1659 by 2212 pixels; retinal fundus photograph; Remidio FOP fundus camera — 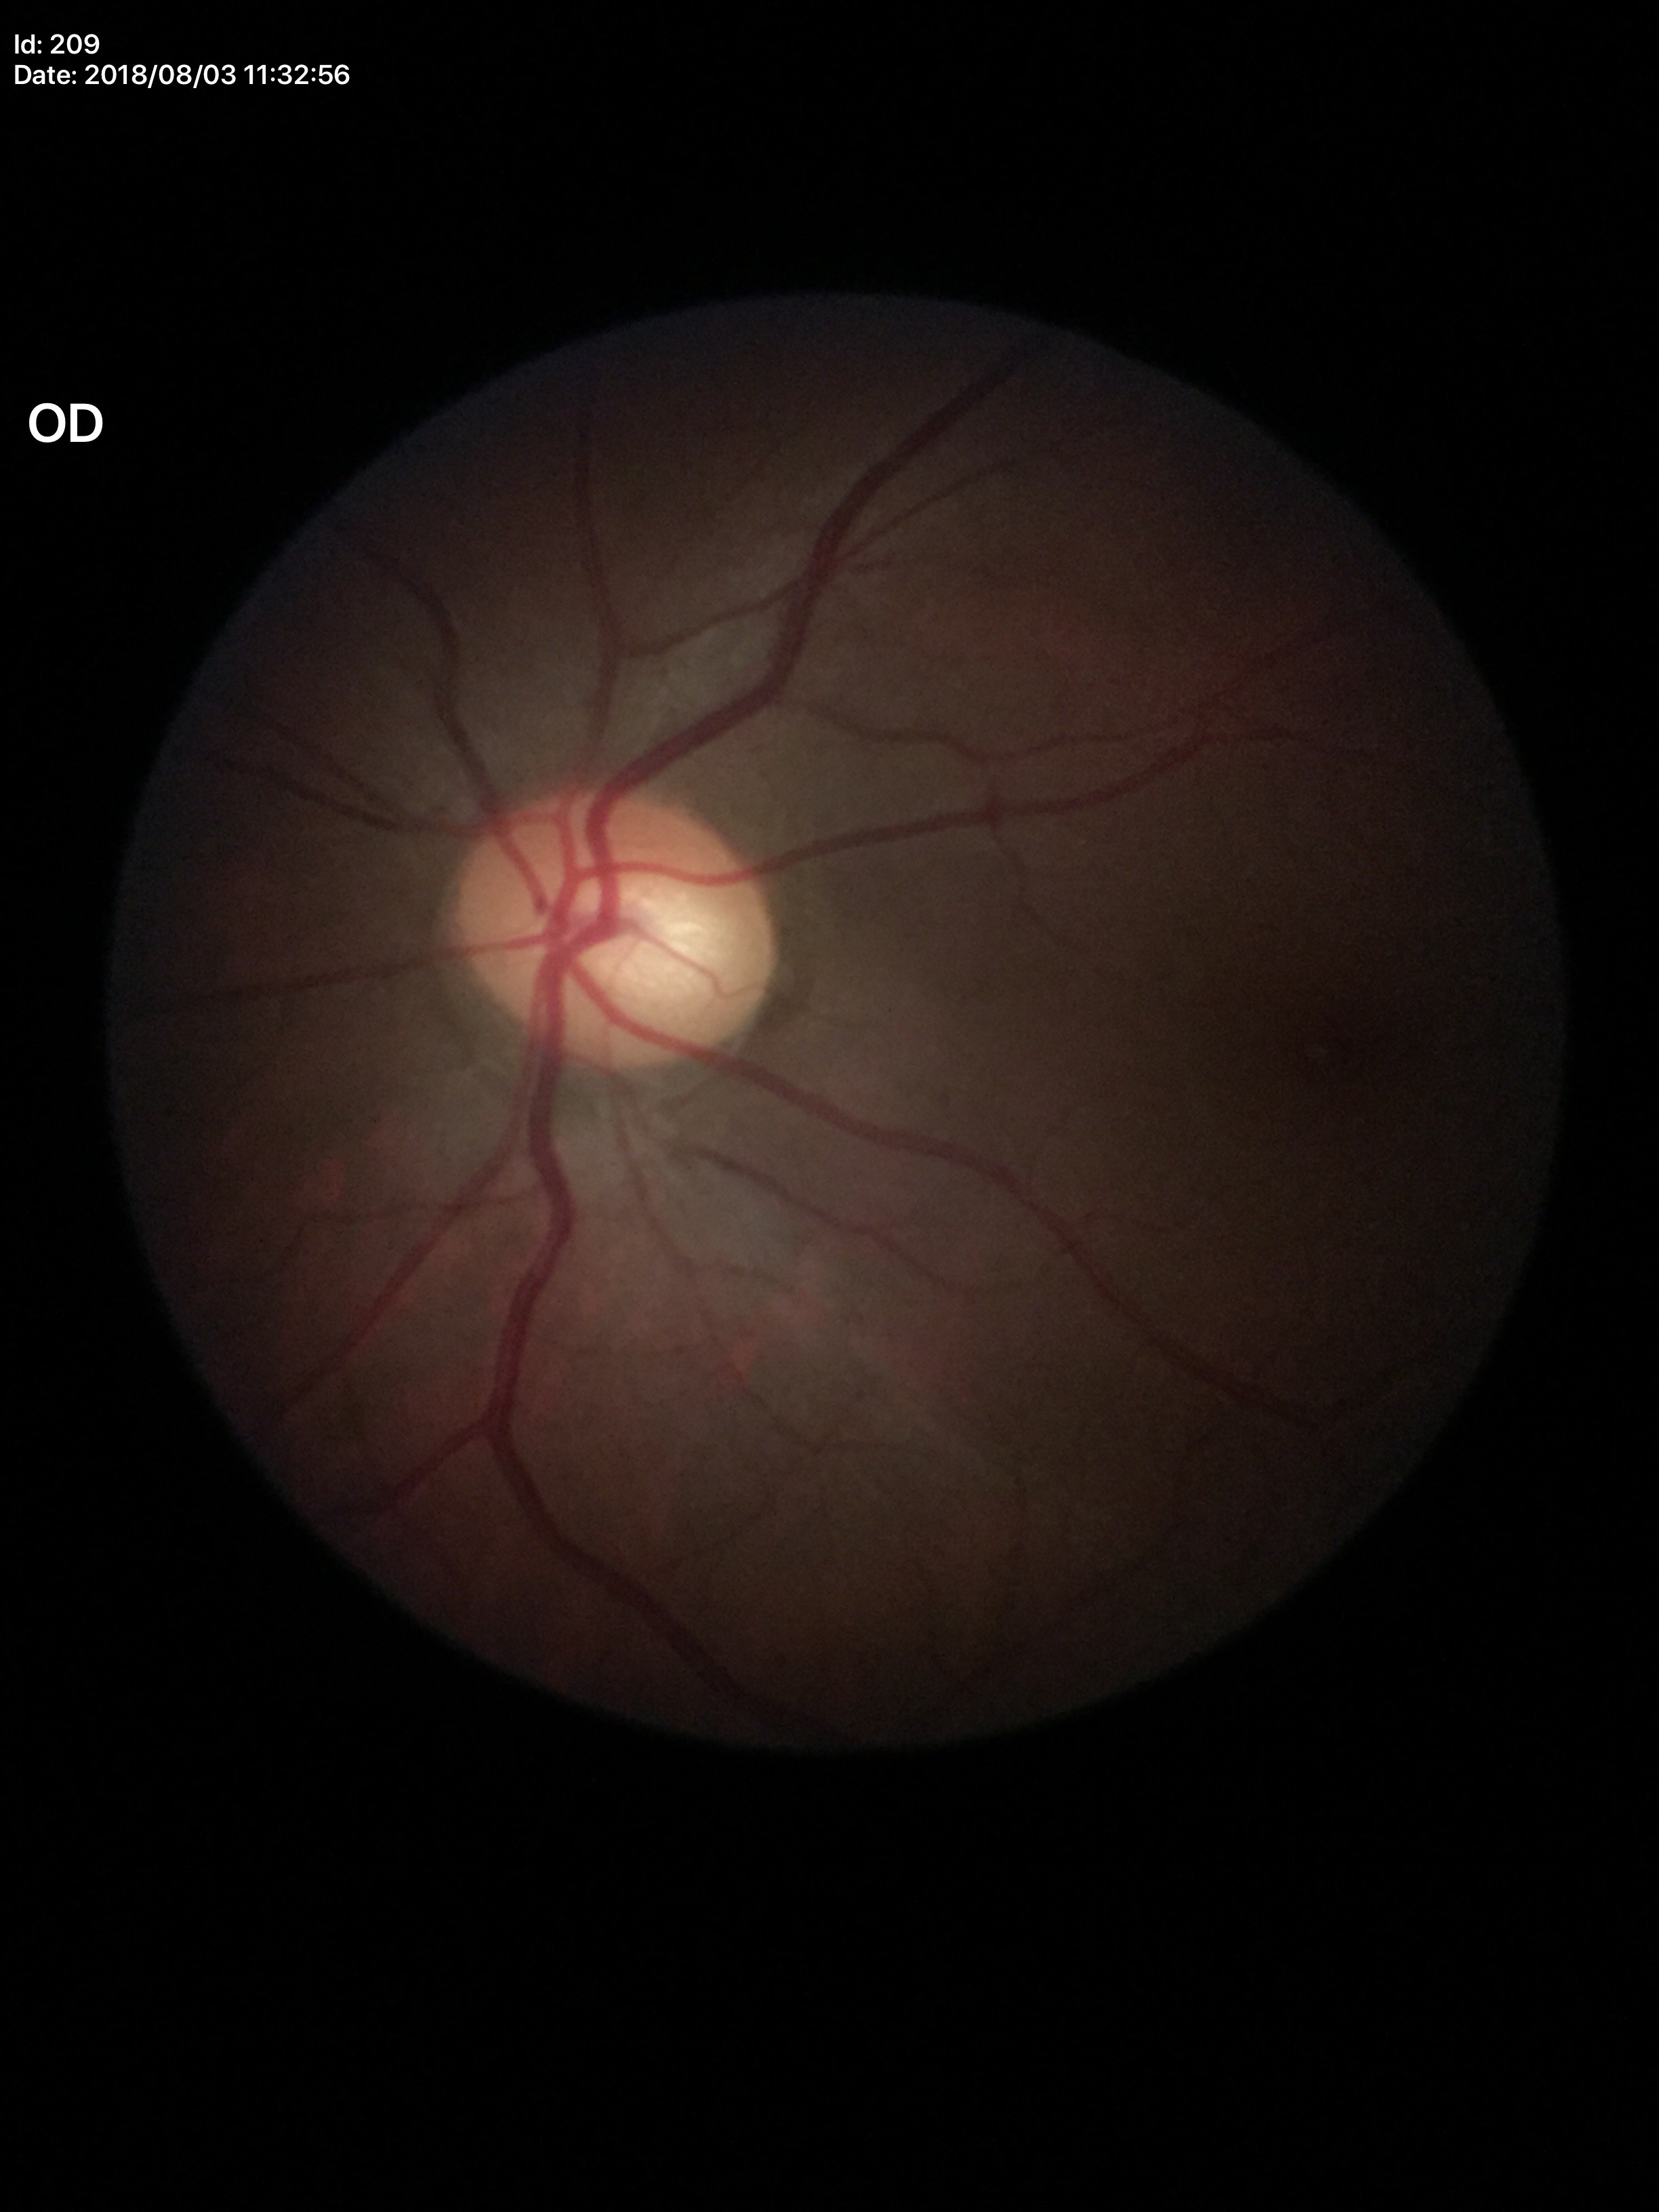

{
  "glaucoma_decision": "negative (unanimous normal call)",
  "hcdr": "0.56",
  "vcdr": "0.54",
  "acdr": "0.31"
}